Fundus photo · acquired with a Kowa VX-10α:
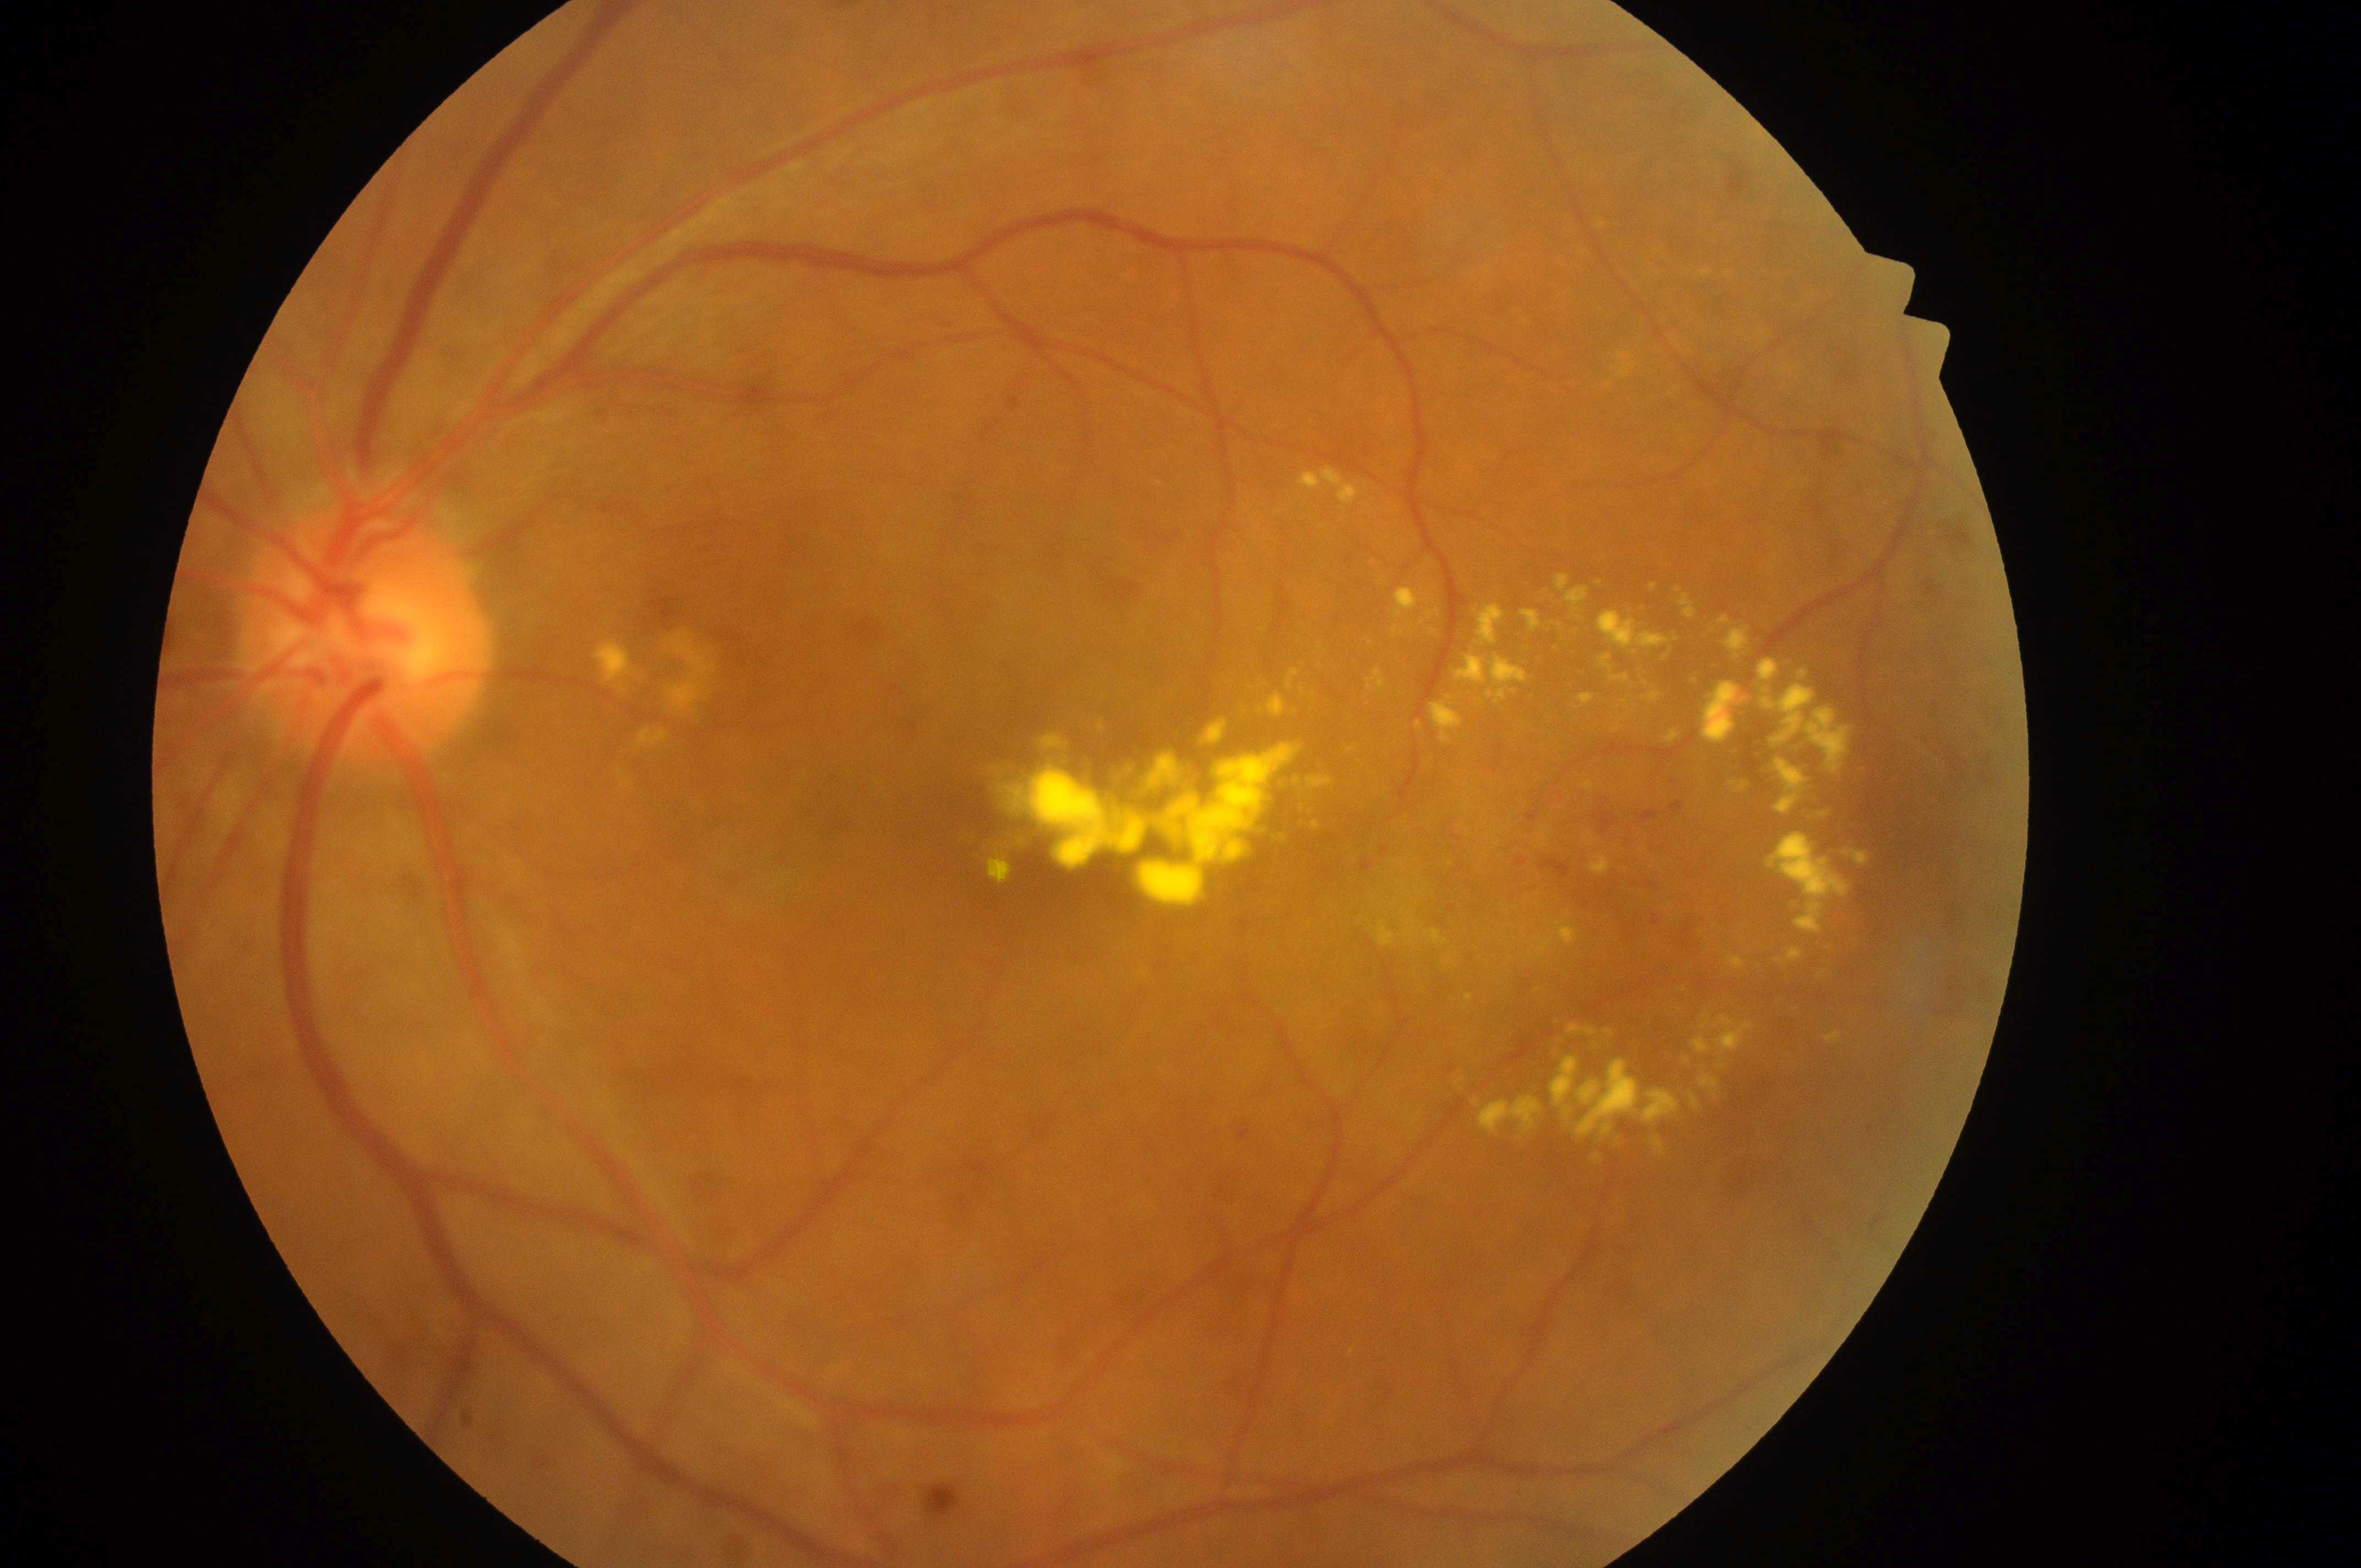
foveal center: x=1064, y=829
laterality: left eye
DR: 2/4
DME: grade 2
ONH: x=363, y=641